Camera: NIDEK AFC-230. 45 degree fundus photograph — 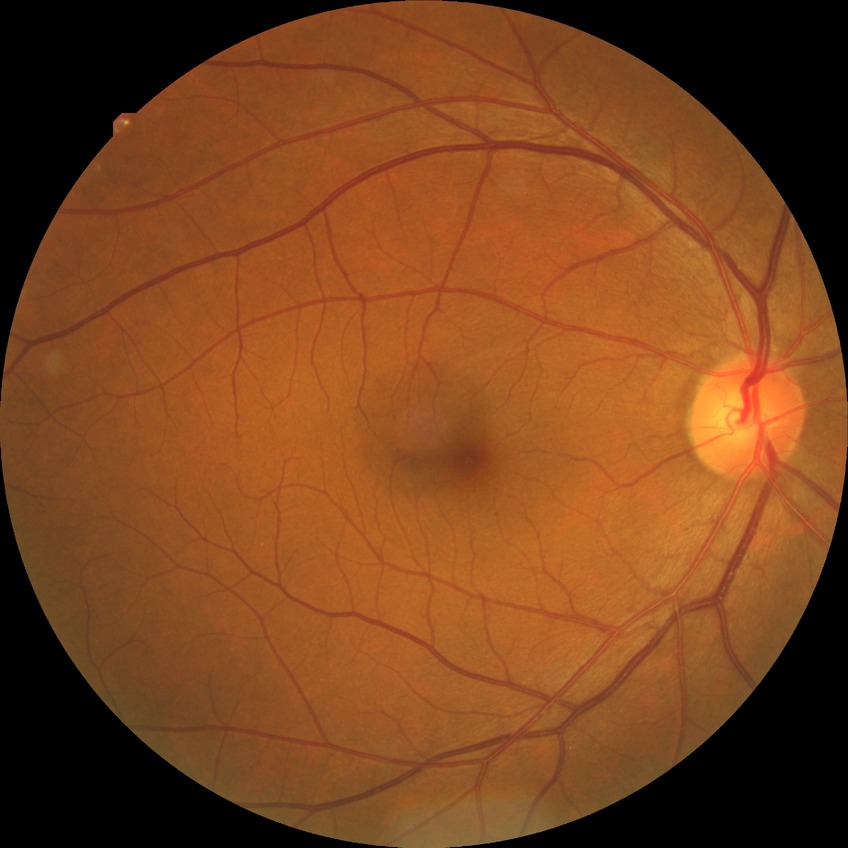
diabetic retinopathy (DR): NDR (no diabetic retinopathy)